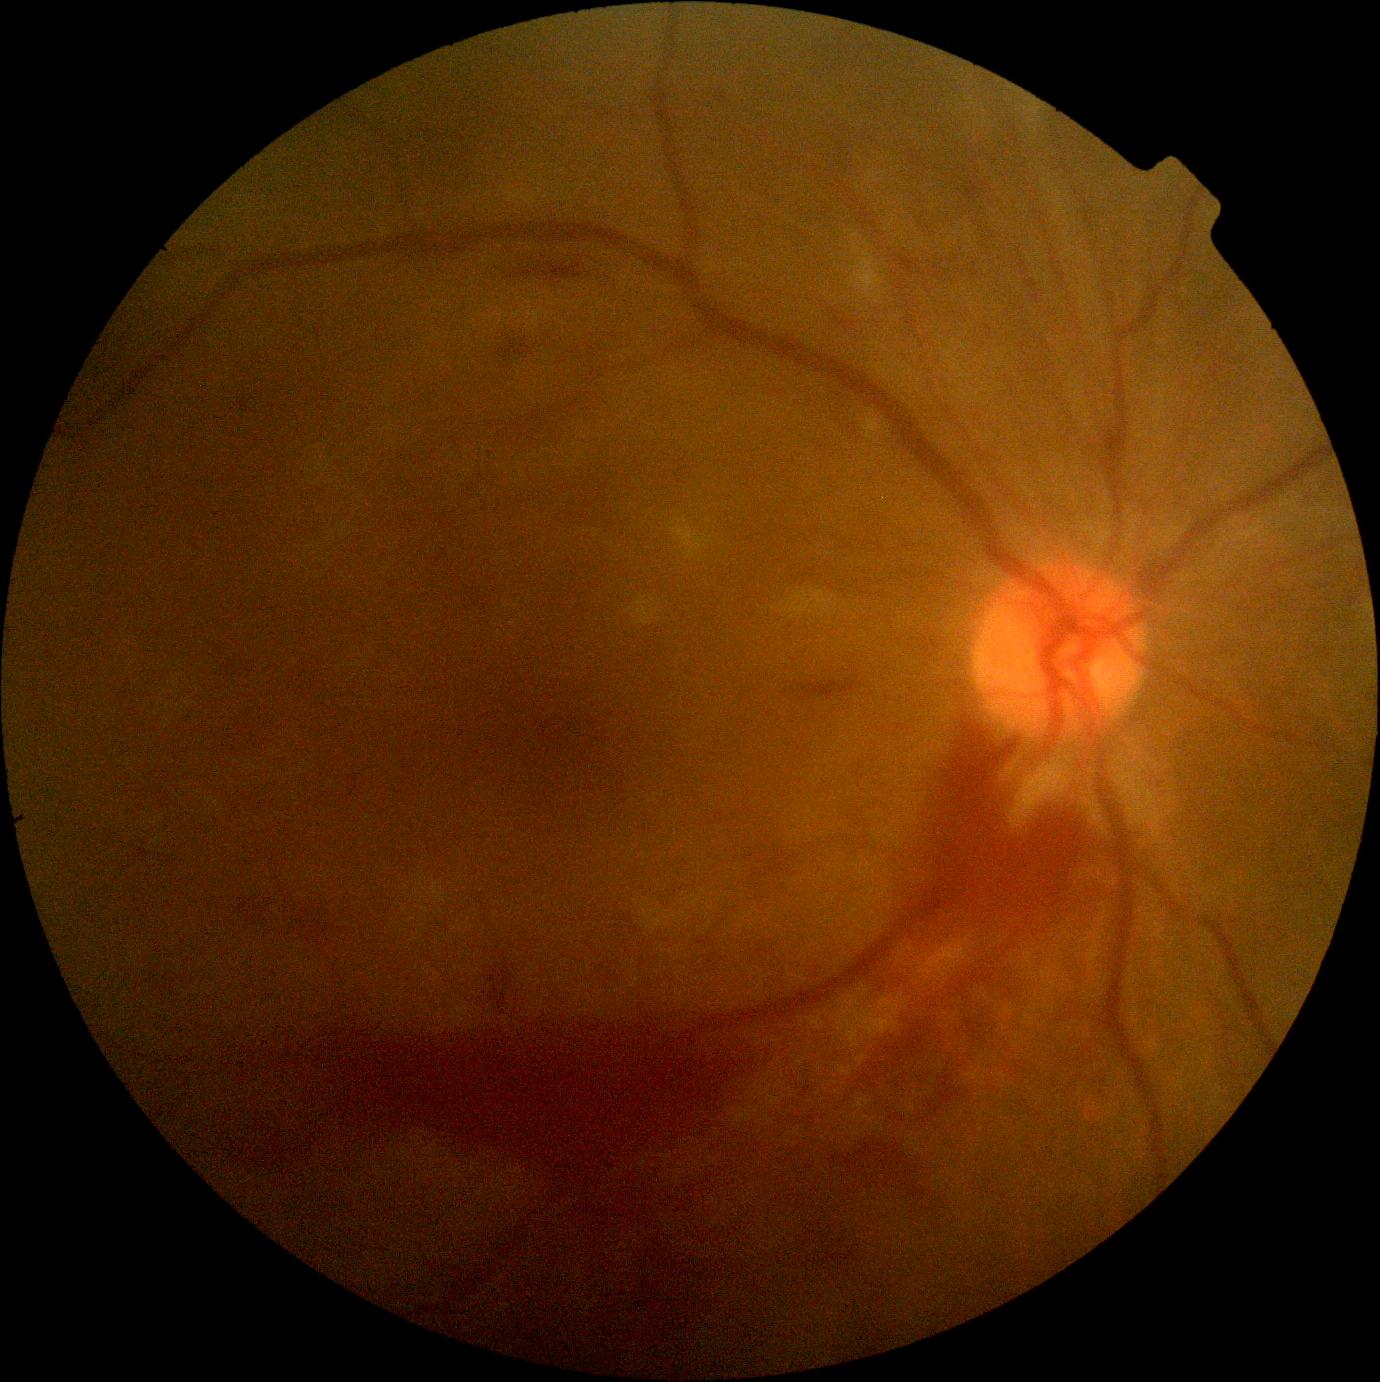

dr_grade: proliferative diabetic retinopathy (4)